2057x1545, color fundus photograph, 45° FOV
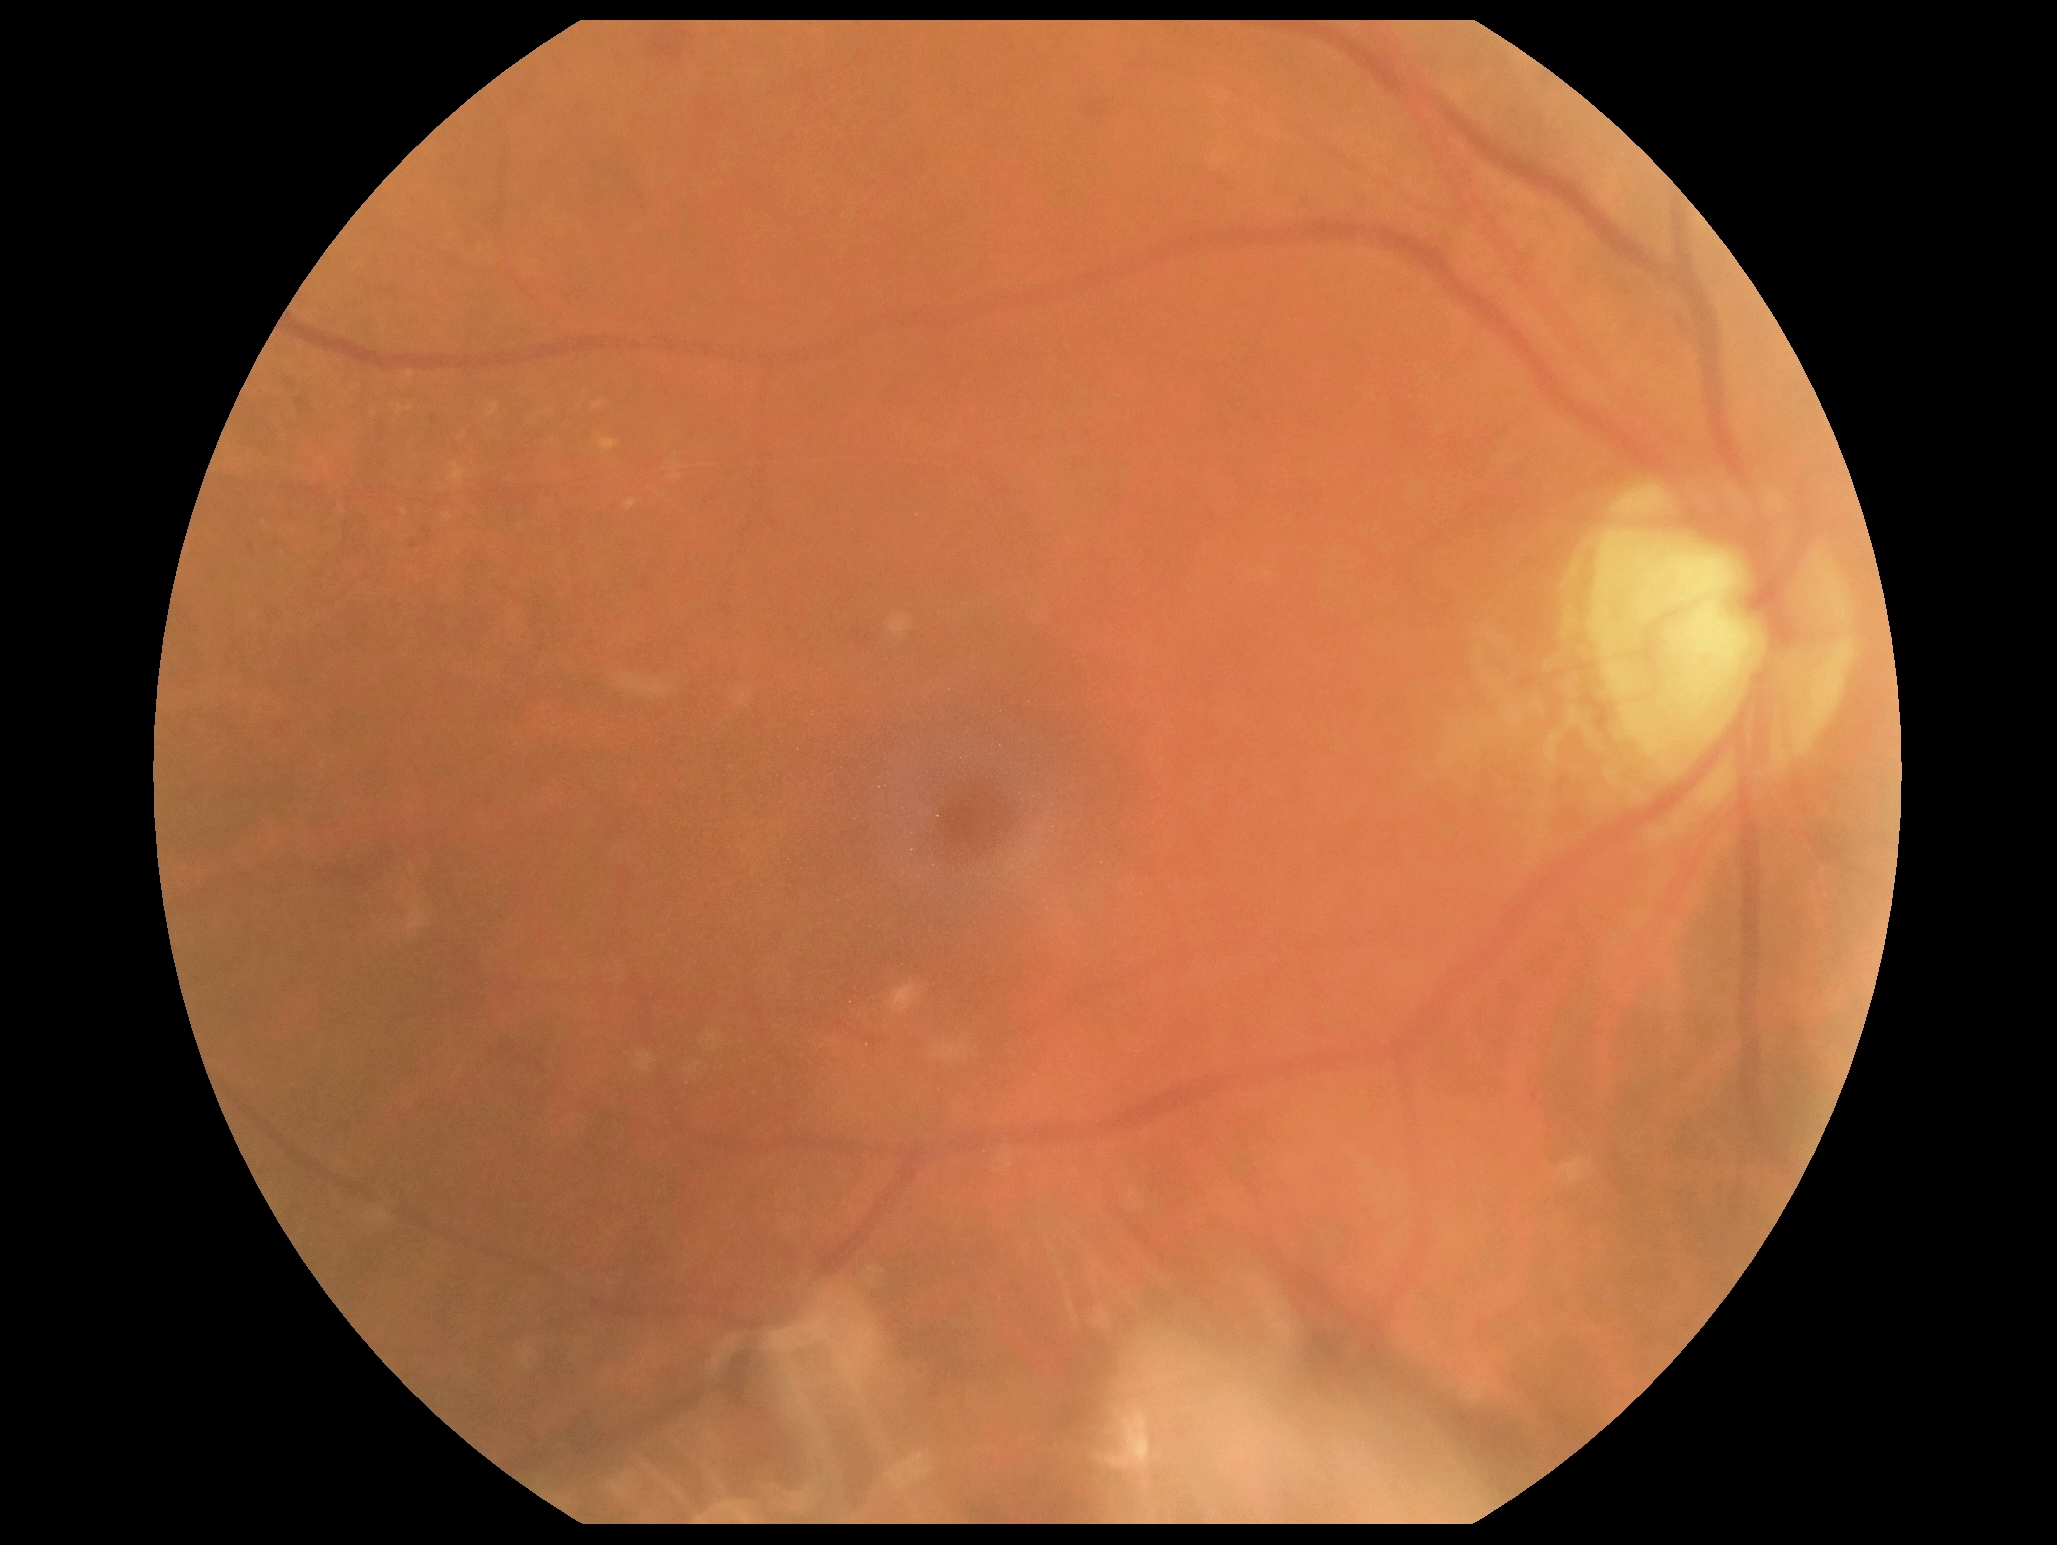 DR stage: grade 2 — more than just microaneurysms but less than severe NPDR; DR class: non-proliferative diabetic retinopathy.